1932 x 1932 pixels, color fundus photograph, FOV: 45 degrees.
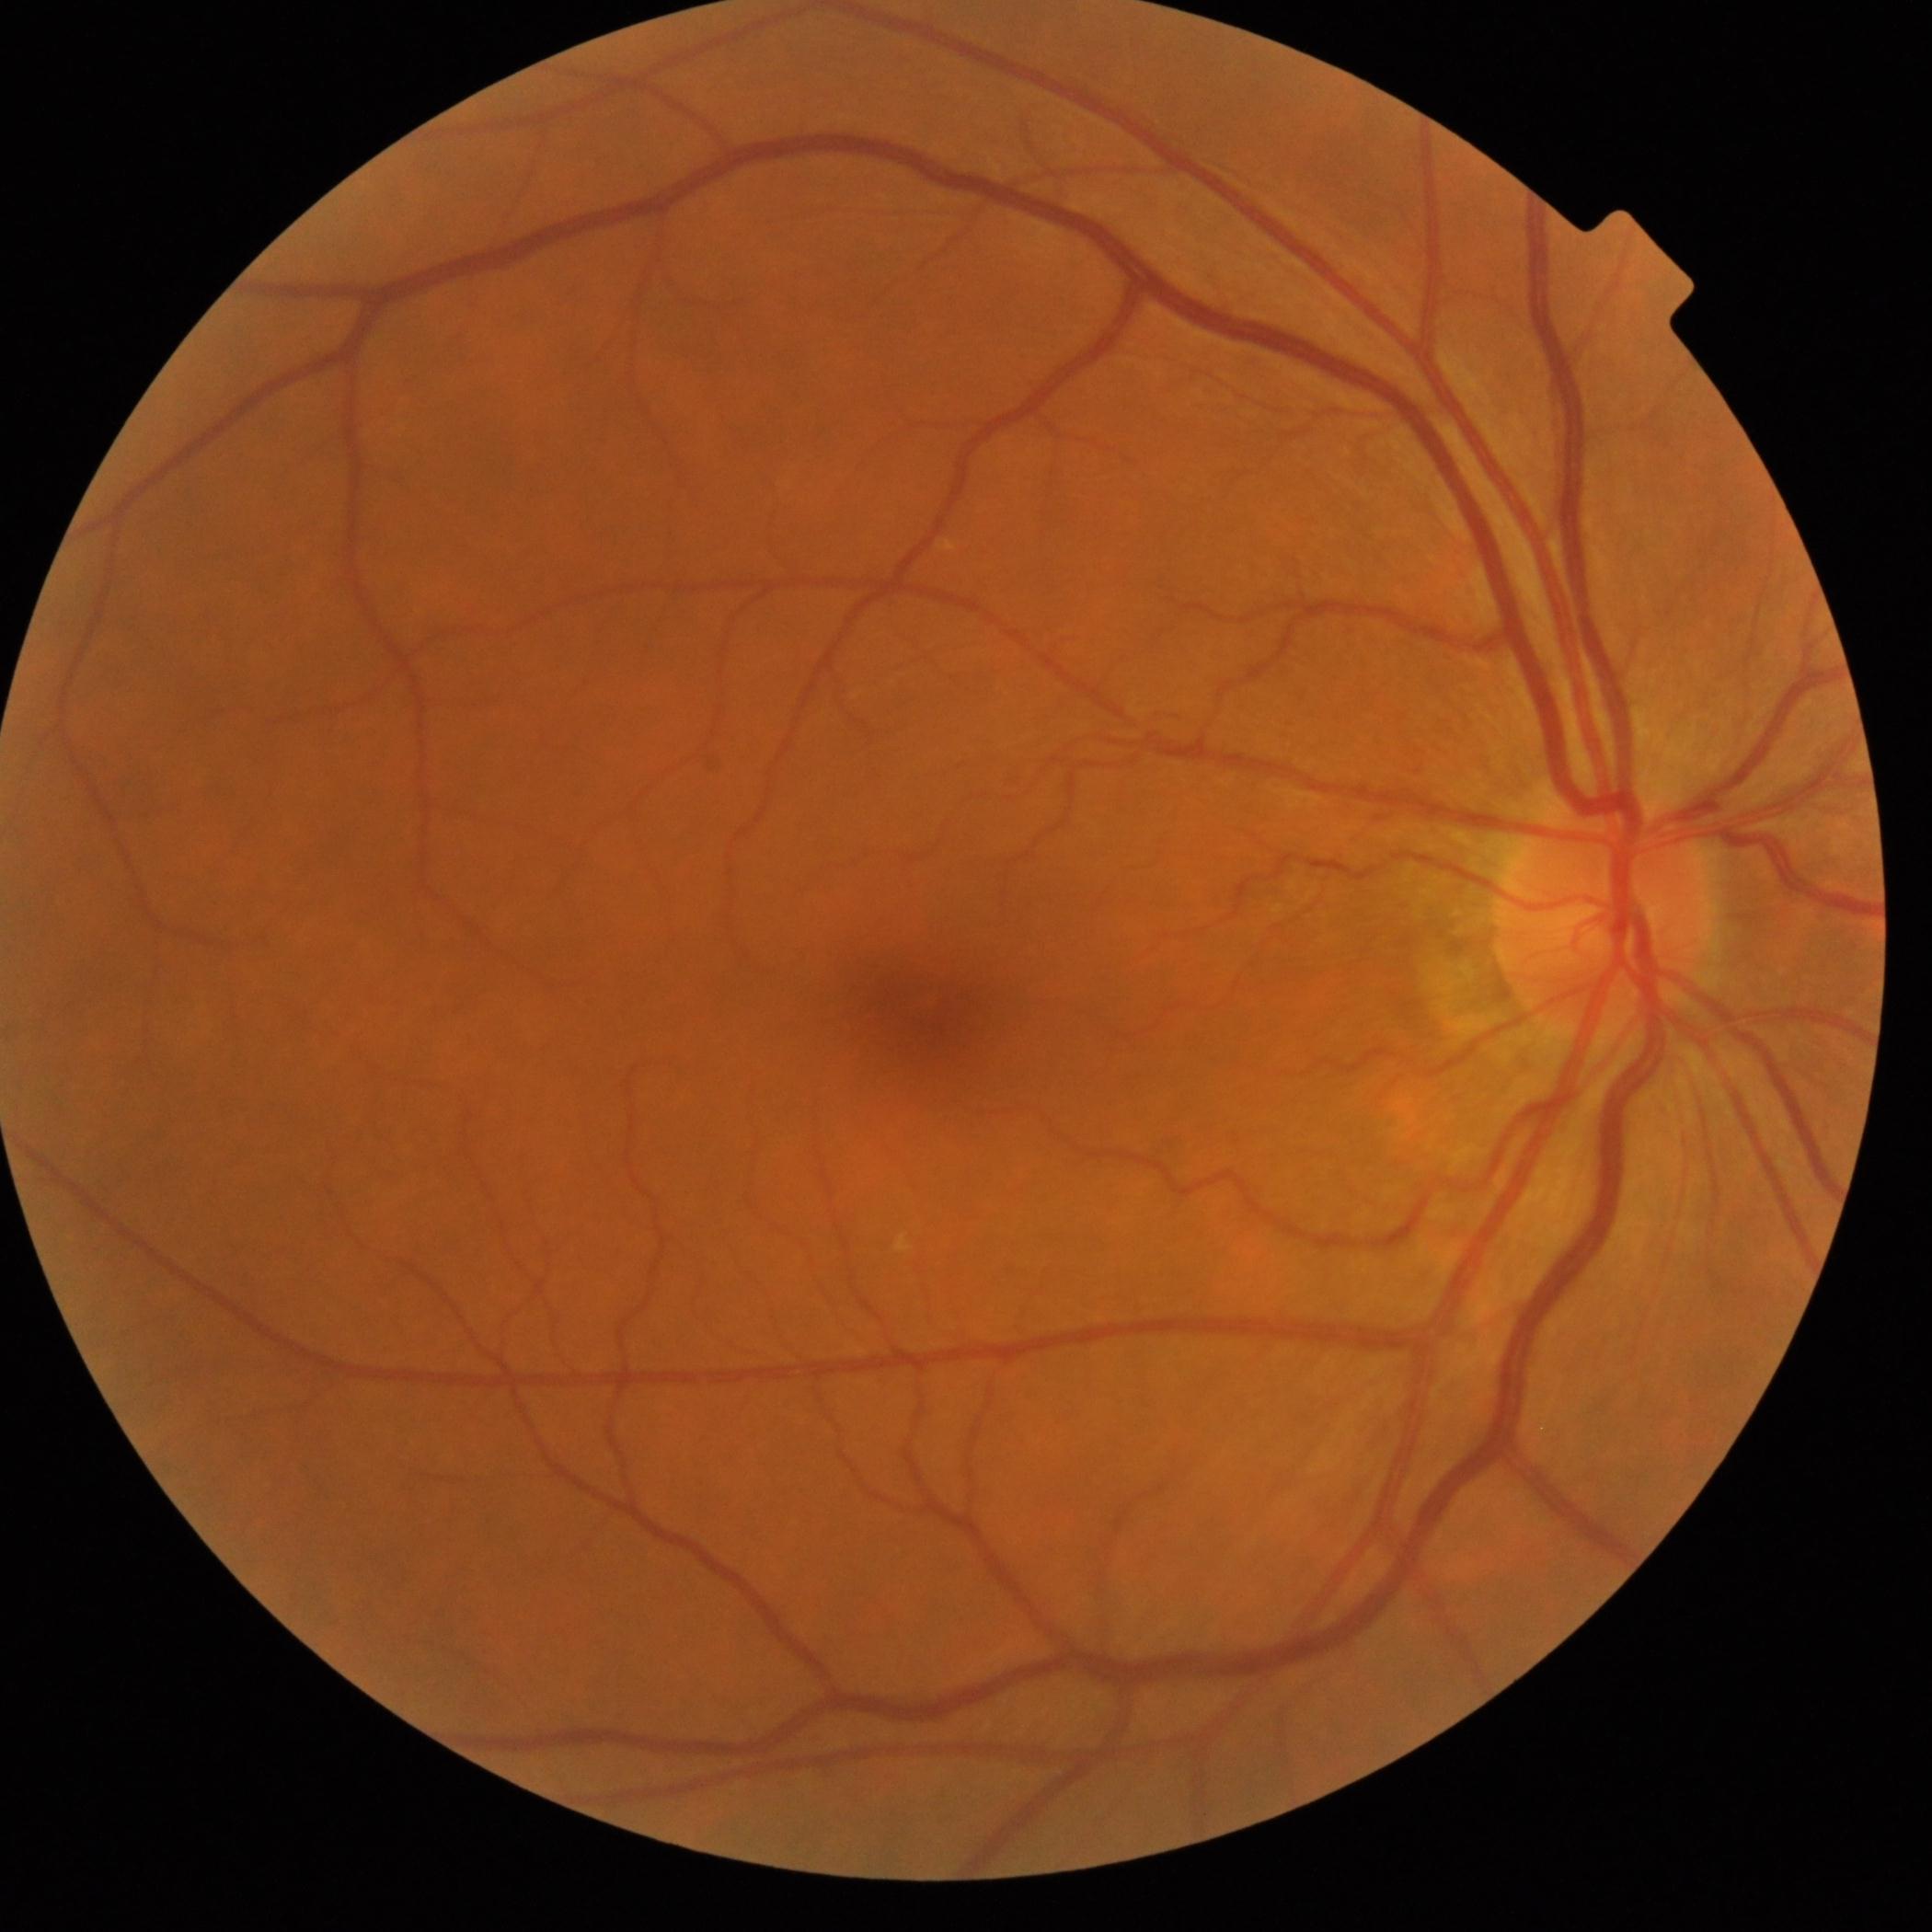
DR: grade 0 (no apparent retinopathy).